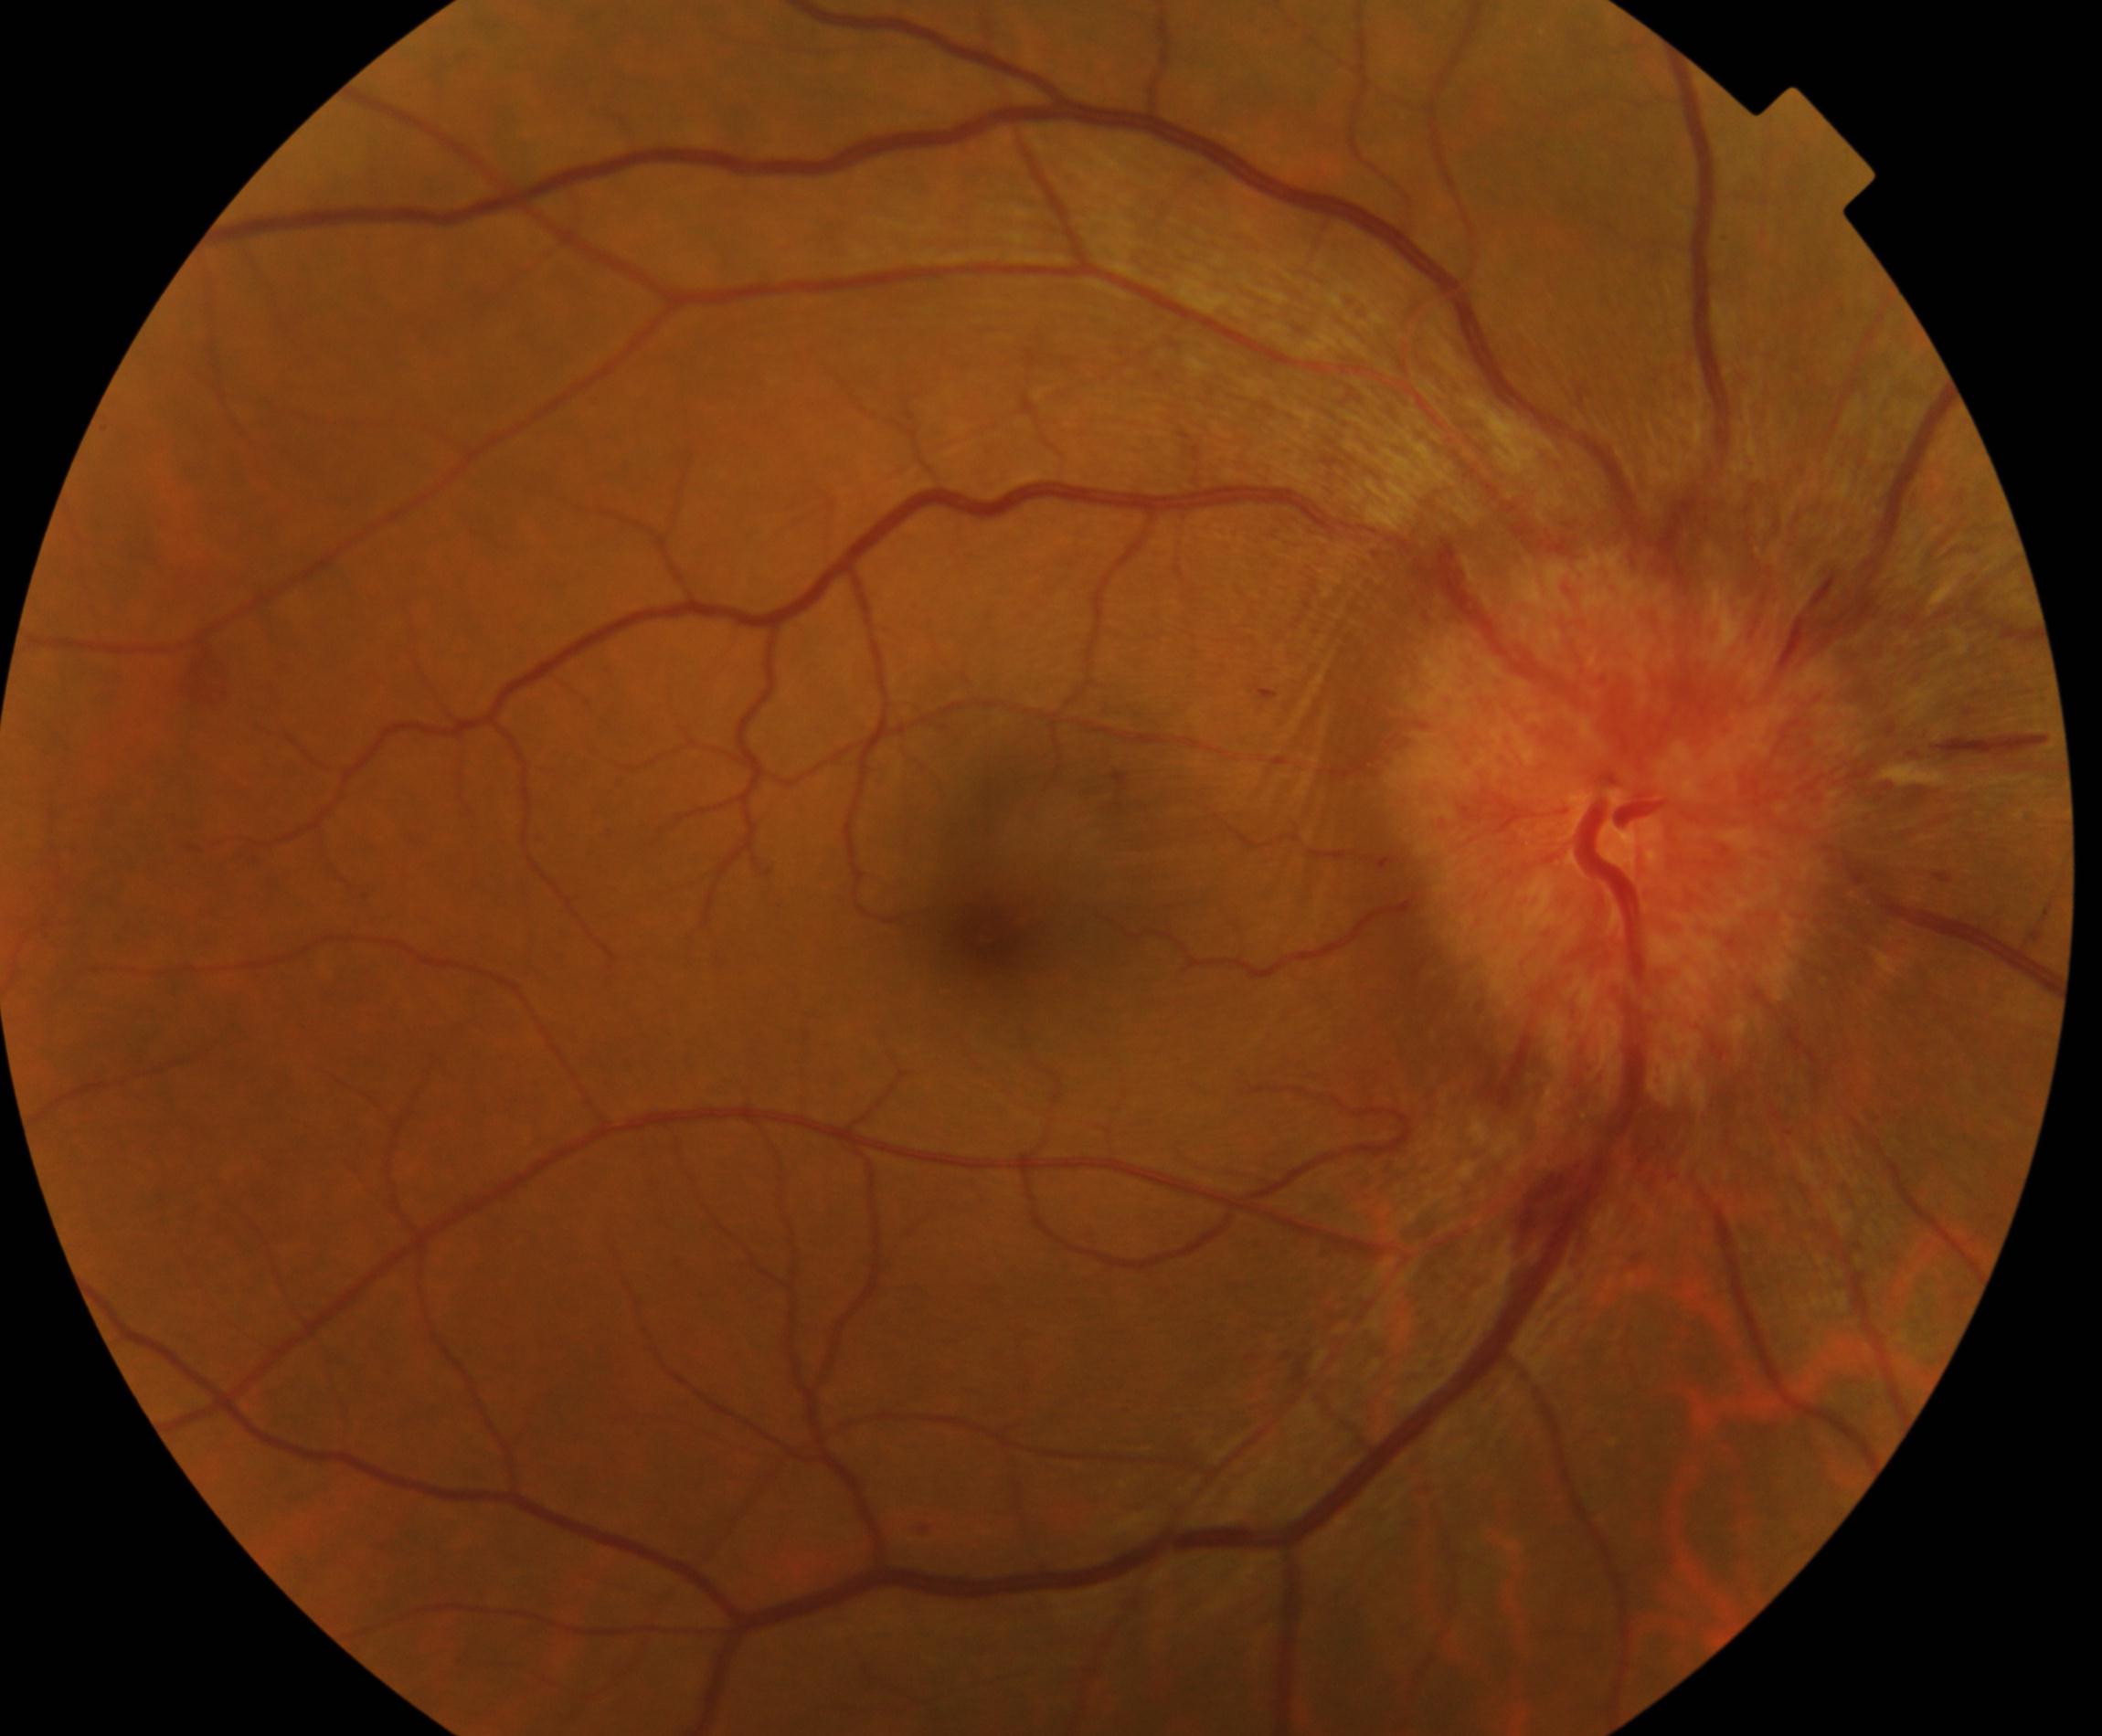
Diagnosis: disc swelling and elevation.